Intraocular pressure (IOP) 22 mmHg. 46-year-old patient. Corneal thickness: 571 µm. Refractive error: -0.5 -0.25 × 95°. Axial length (AL) 23.23 mm
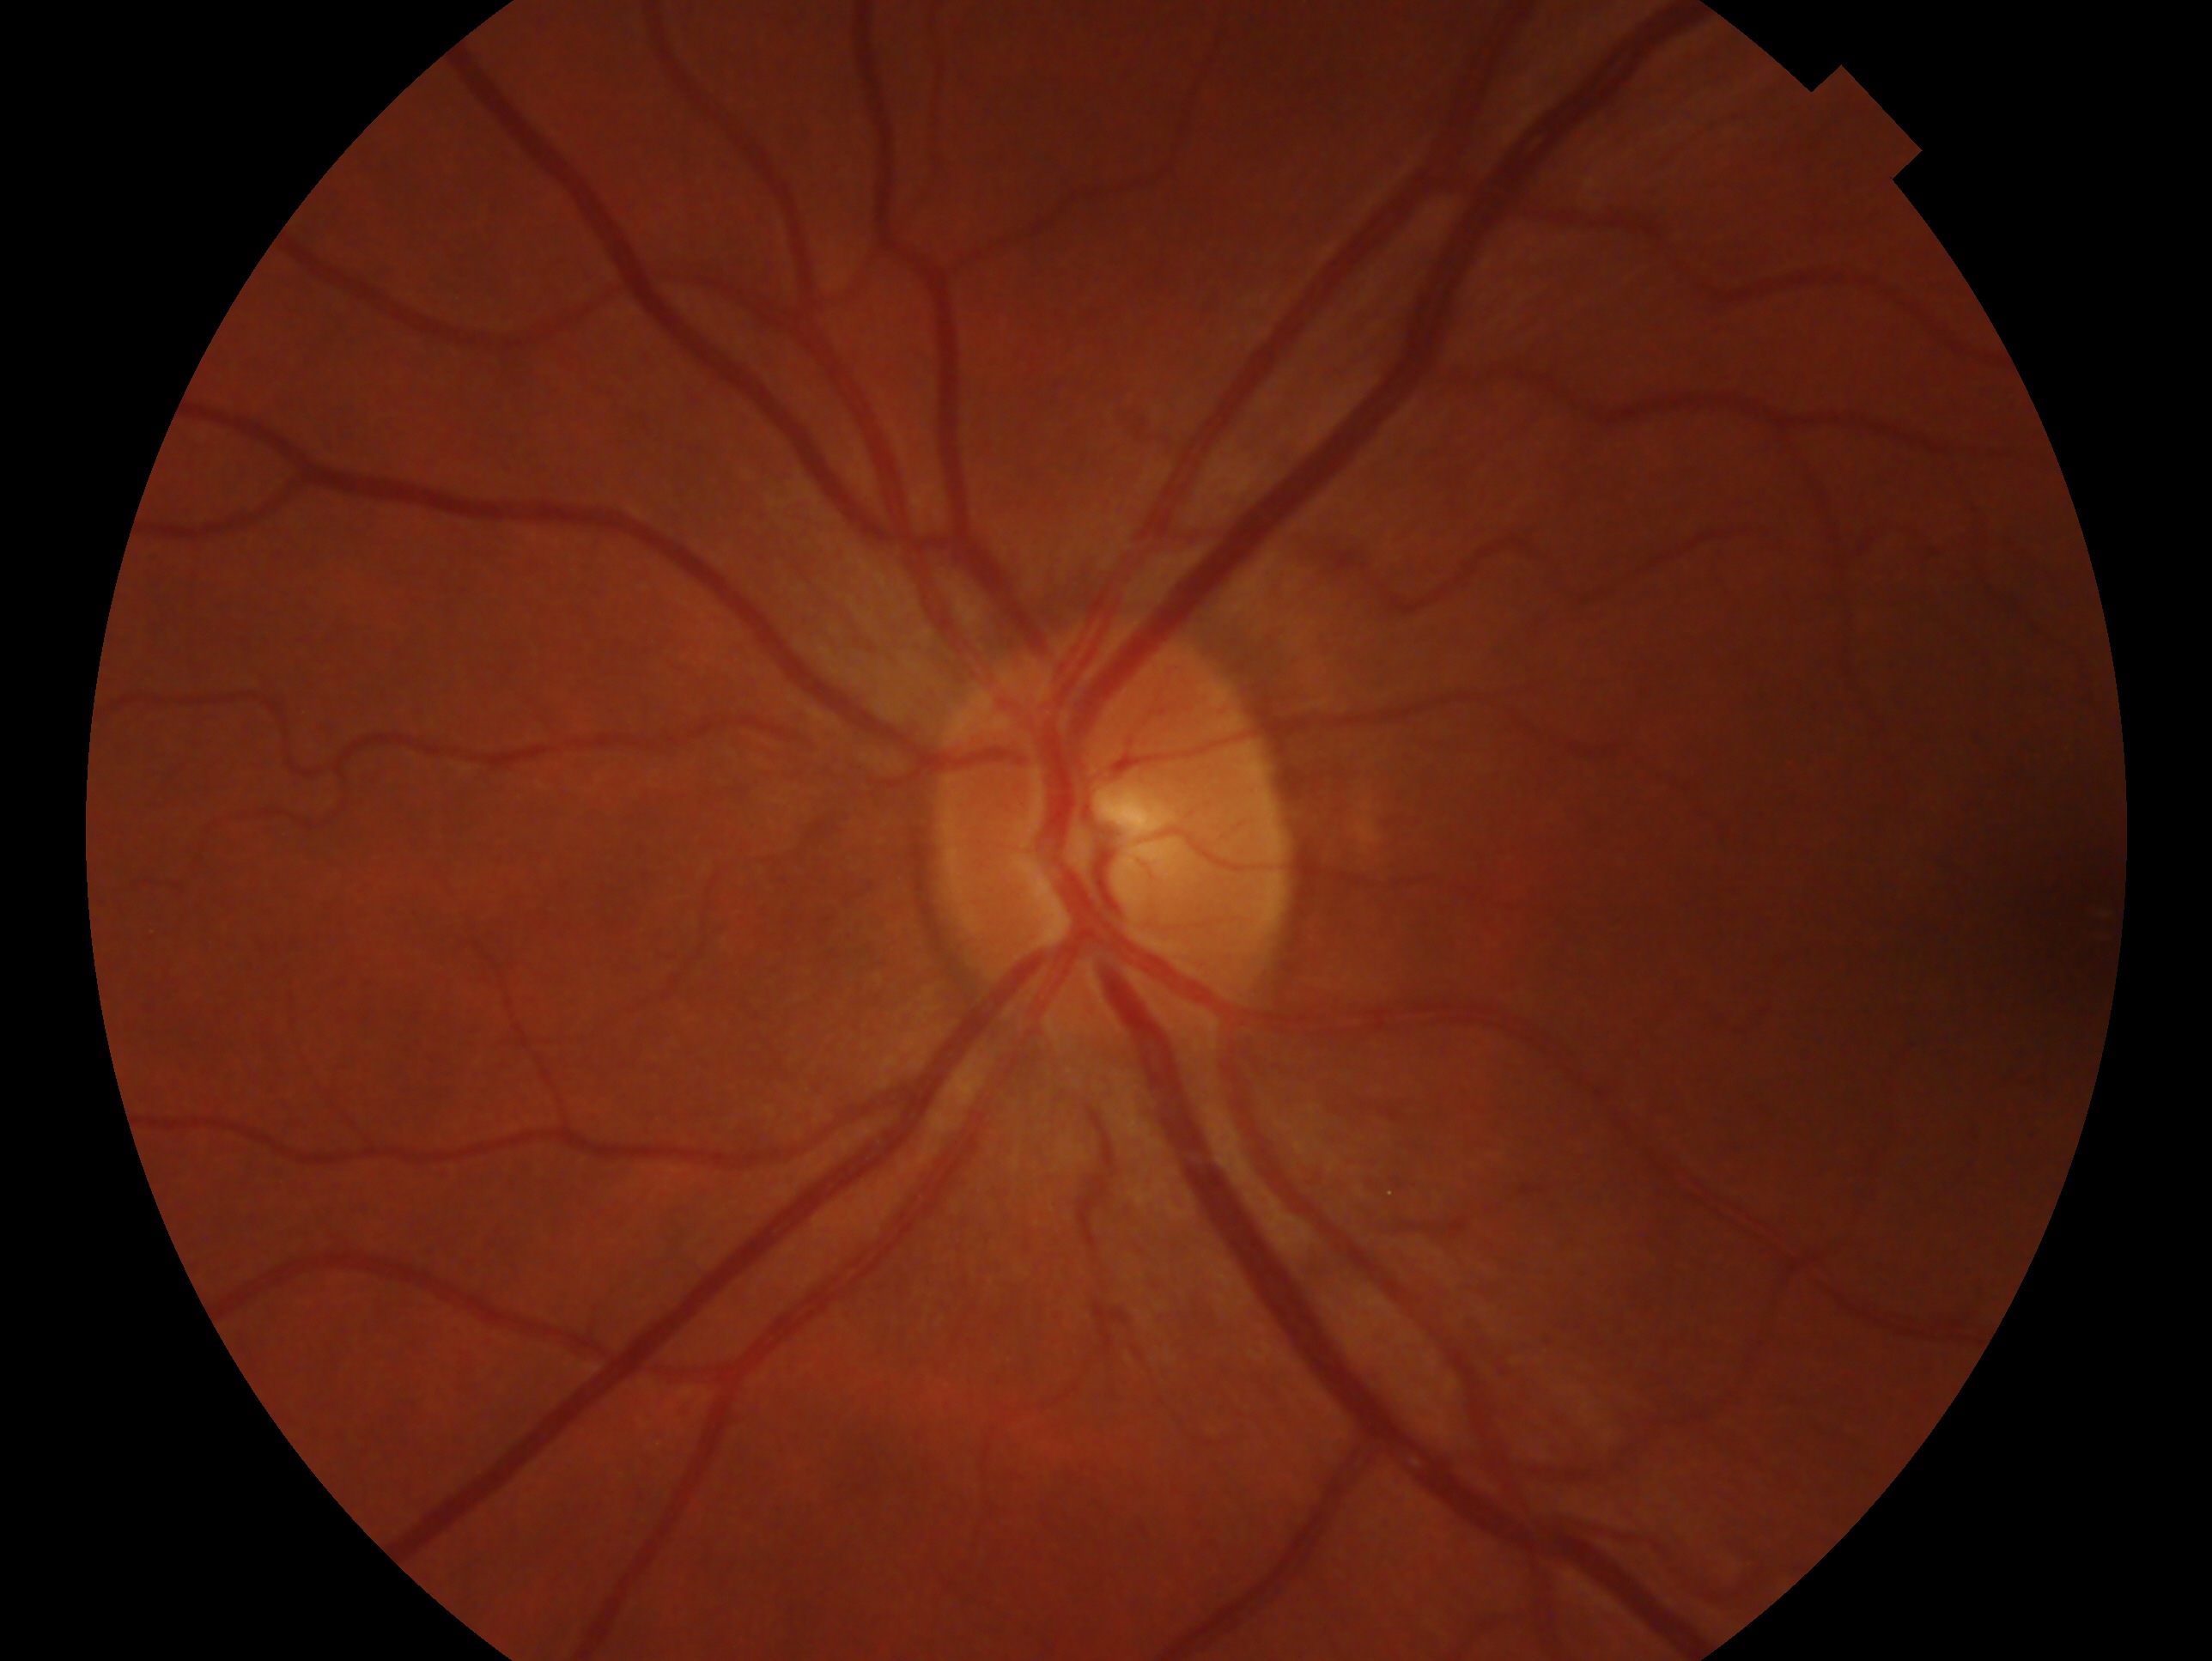 Annotations:
- laterality: left eye
- assessment: no glaucomatous findings